848x848; camera: NIDEK AFC-230; 45-degree field of view; nonmydriatic fundus photograph:
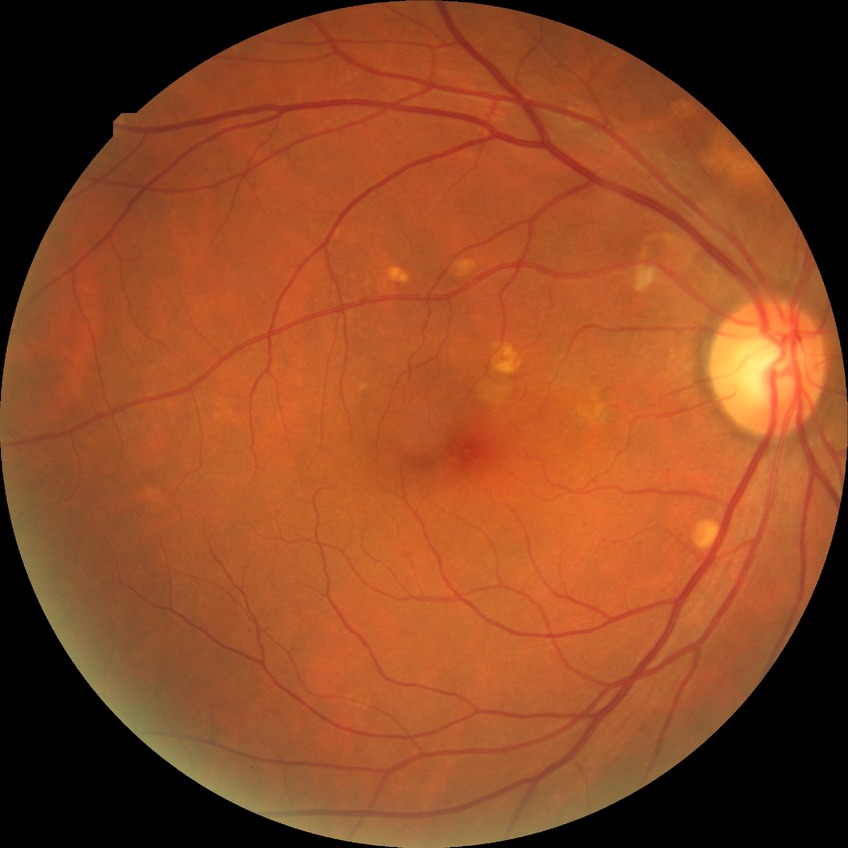

{"davis_grade": "no diabetic retinopathy"}